Color fundus photograph:
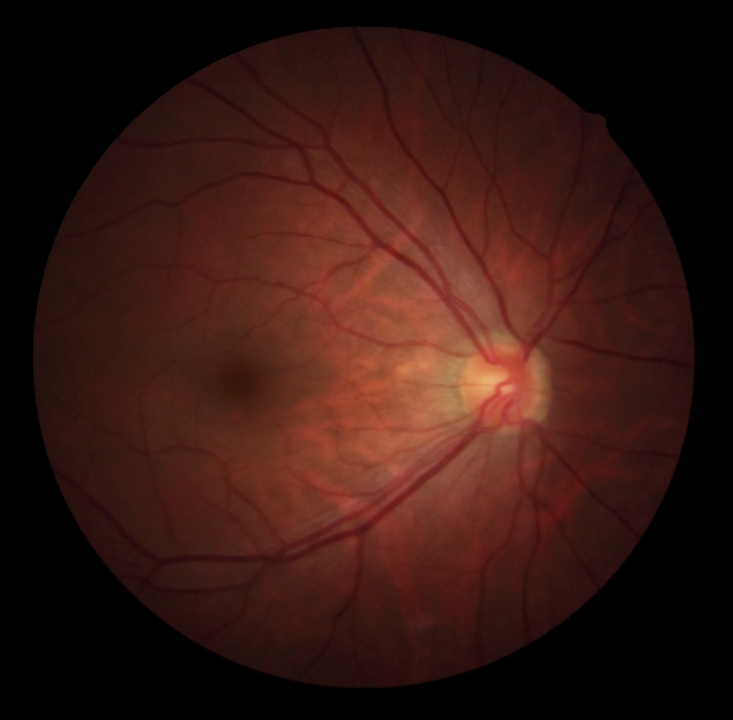 Retinopathy is 0.